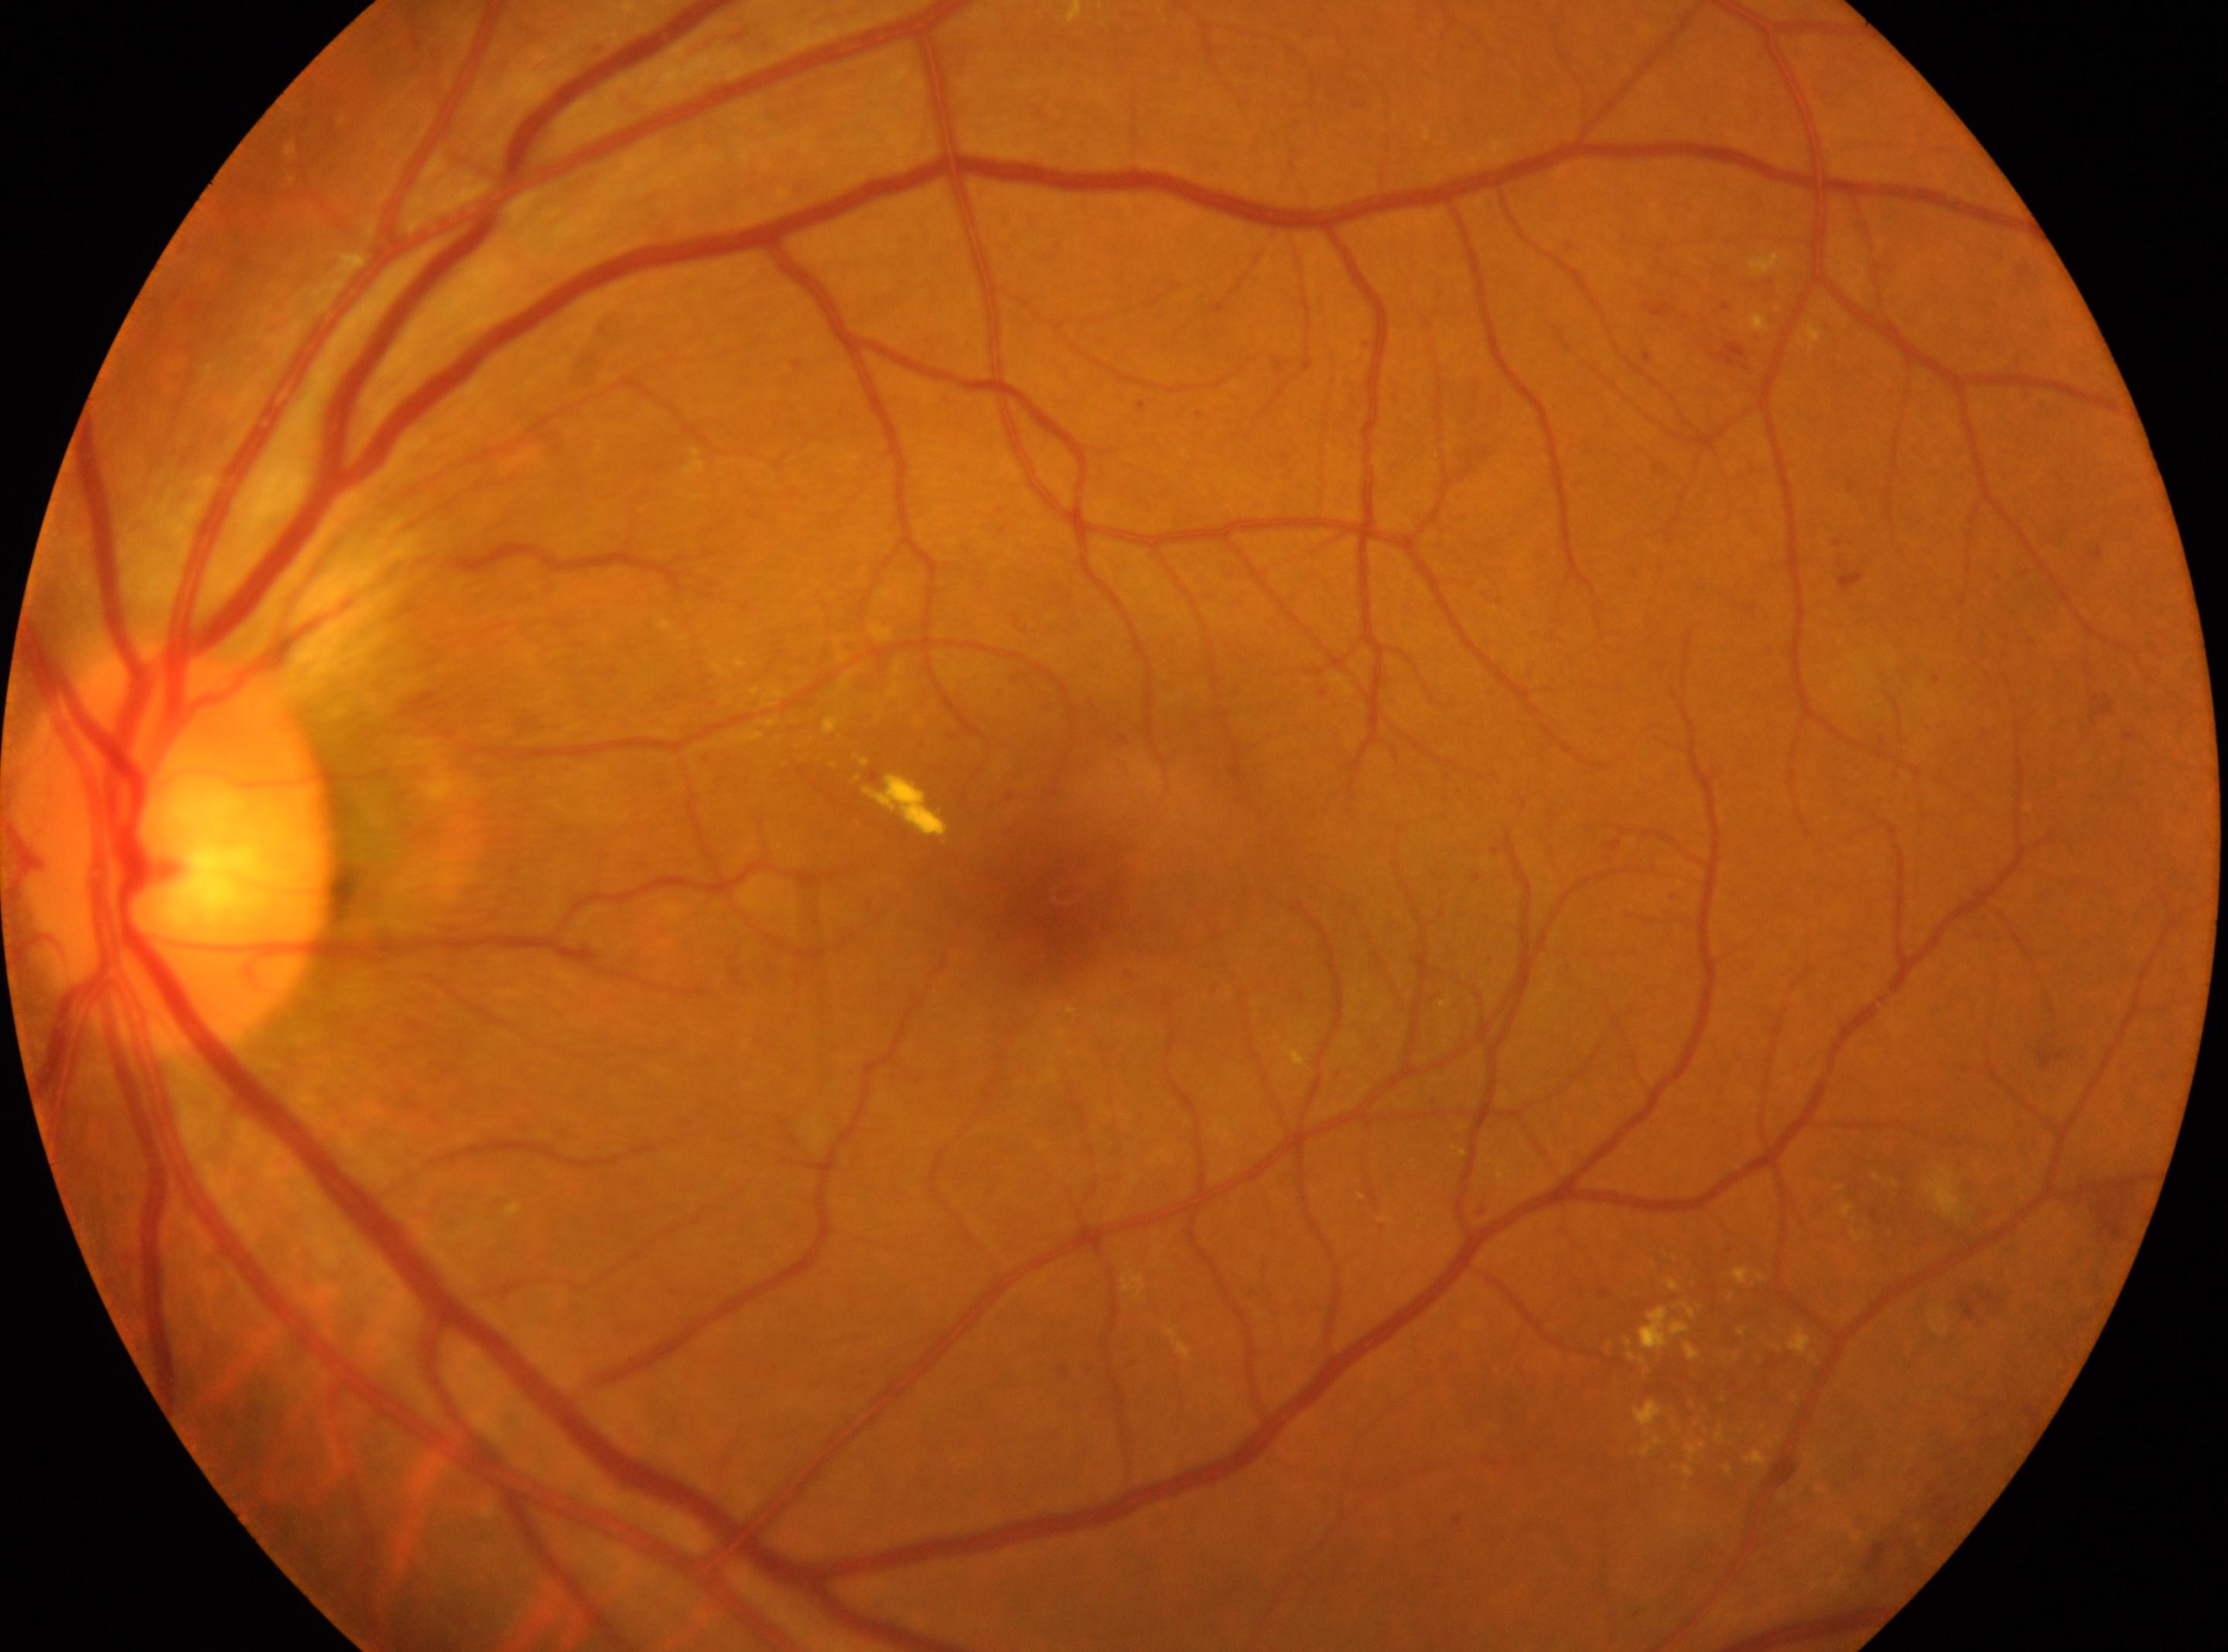

Foveal center: 1051, 900. DR stage is 2. DR class: non-proliferative diabetic retinopathy. Eye: OS. Disc center located at 178, 846.